Fundus photo; 1534 by 1534 pixels; 50-degree field of view: 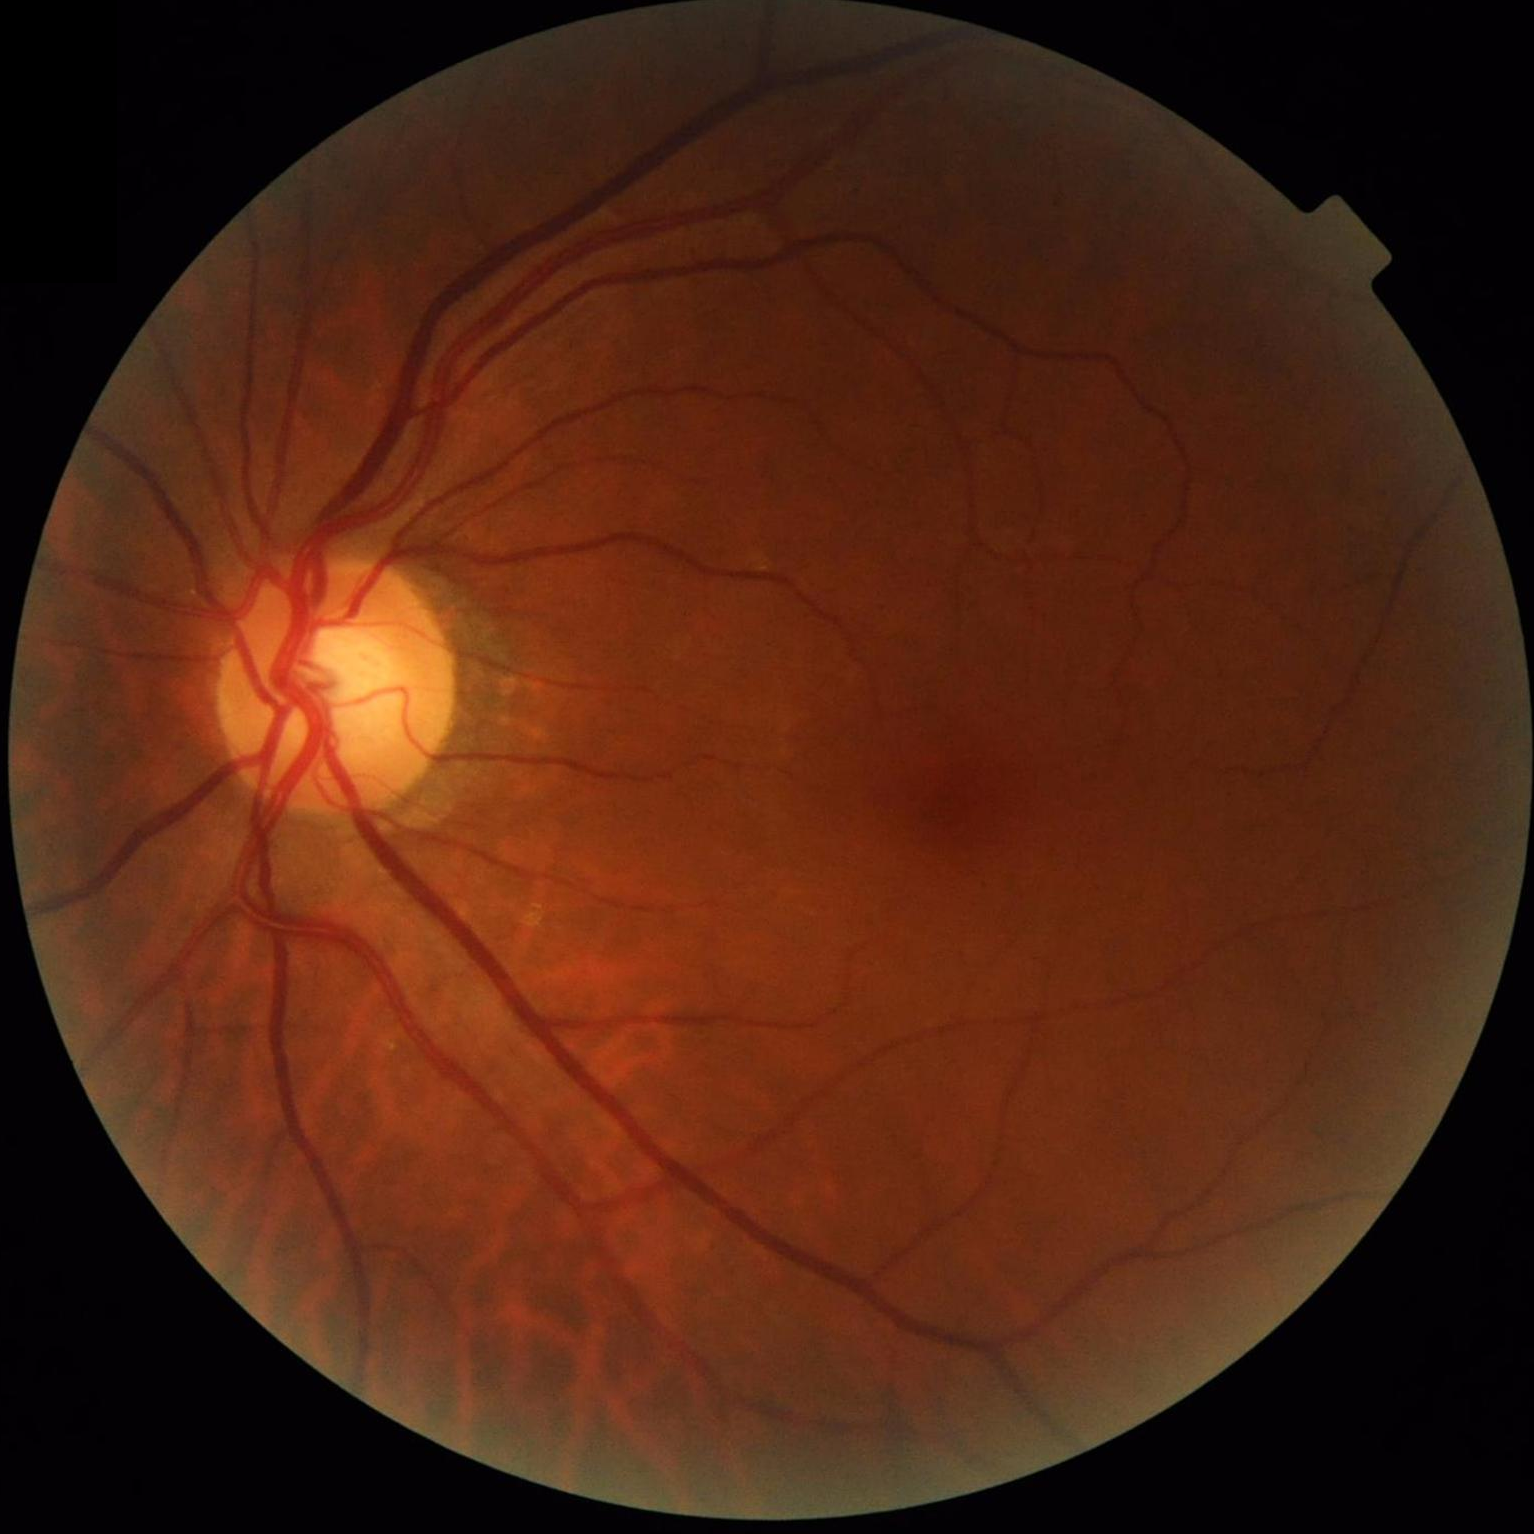
Even illumination with no color cast.